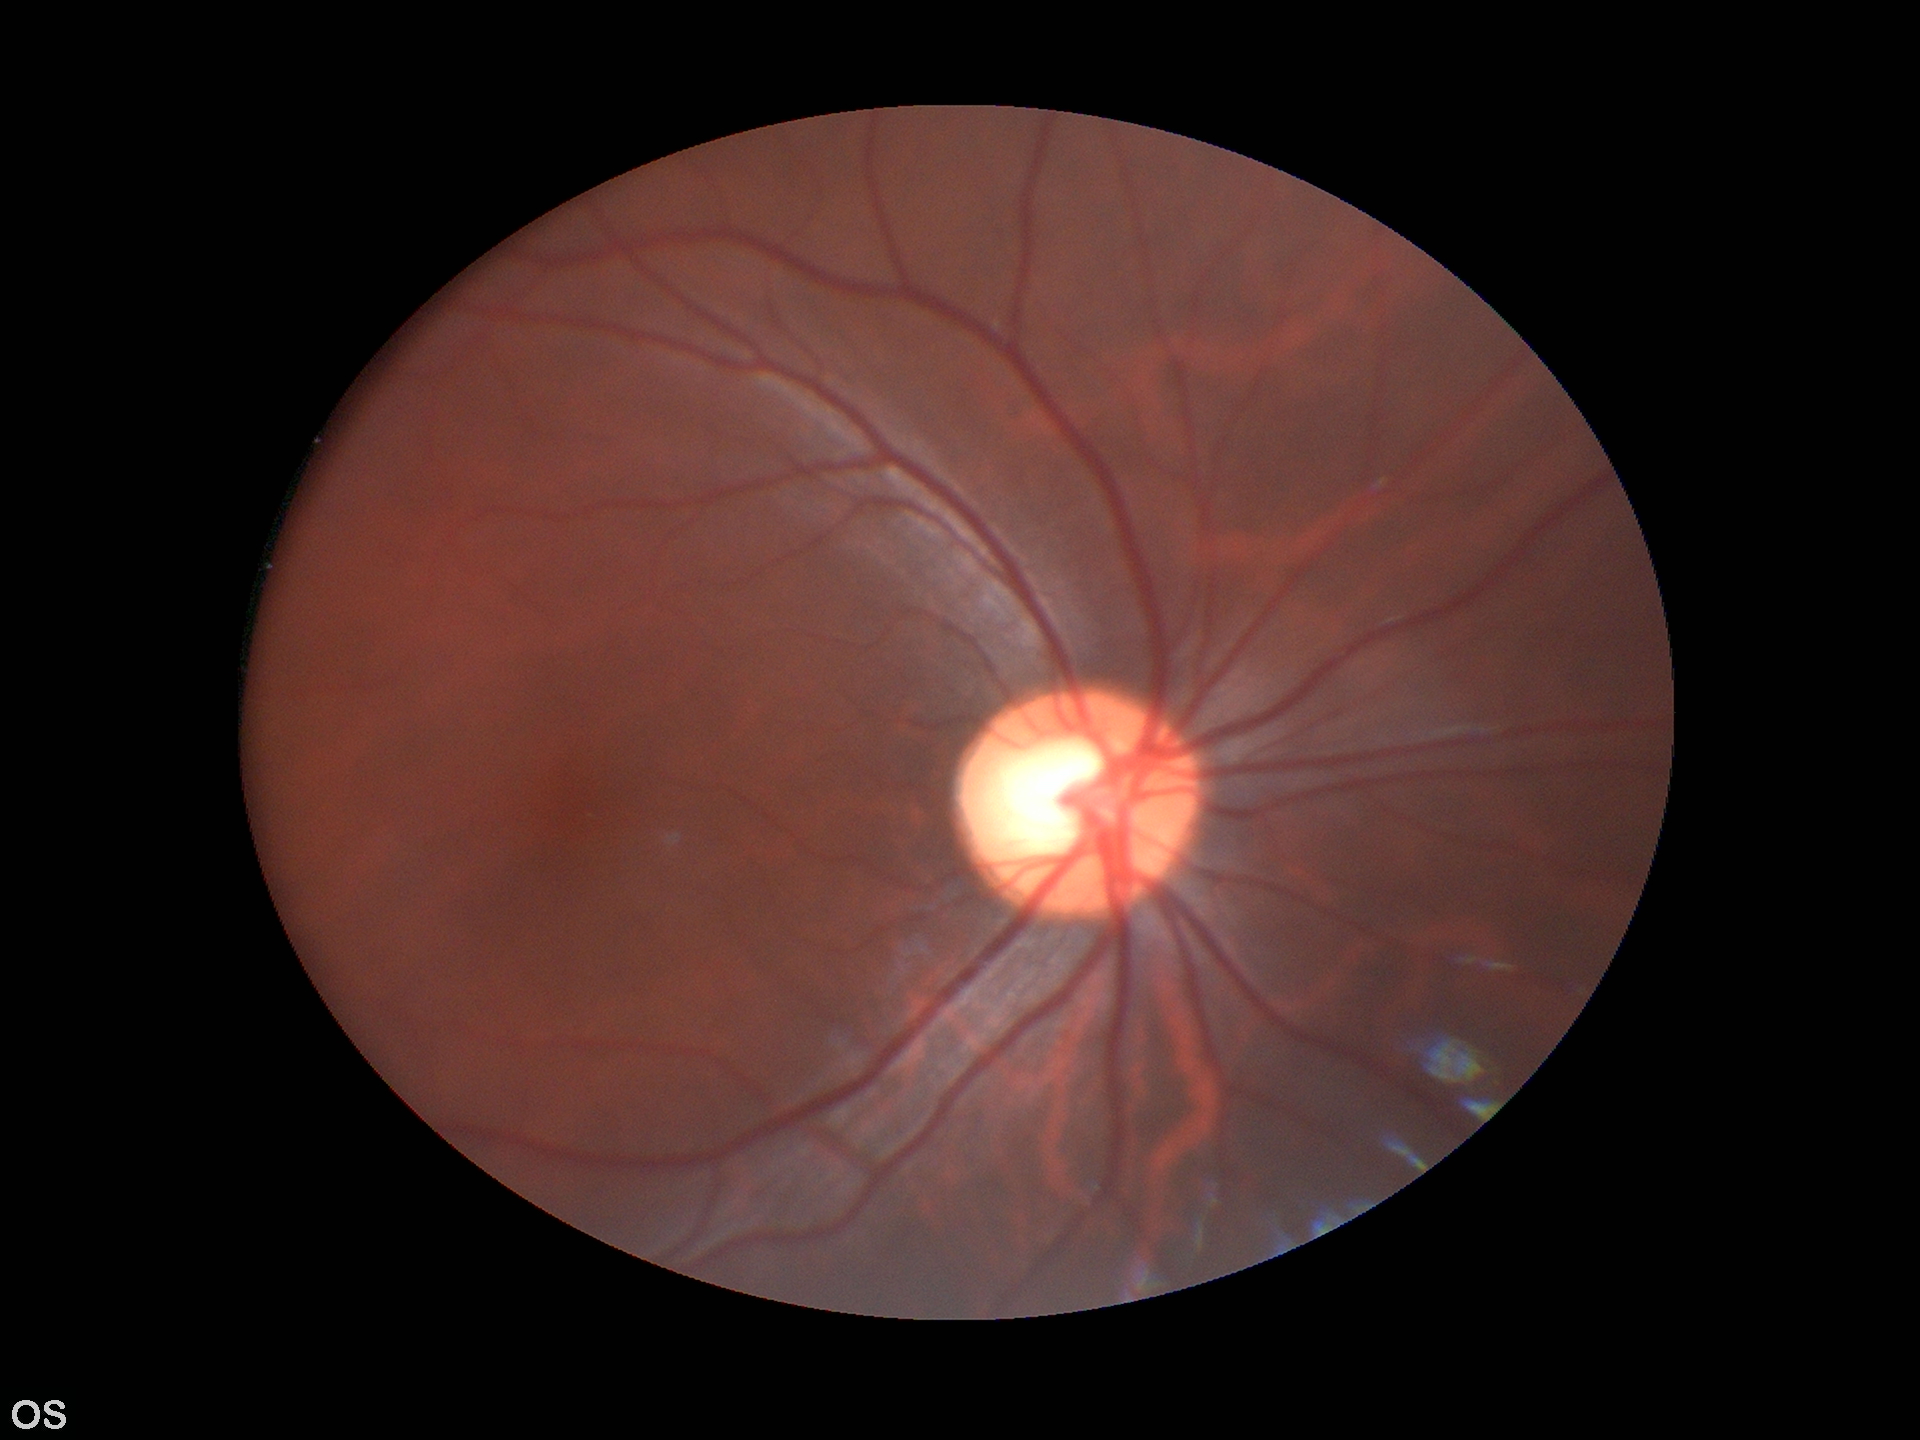
Vertical CDR: 0.59. Glaucoma decision: negative.